2048 by 1536 pixels · 45° FOV
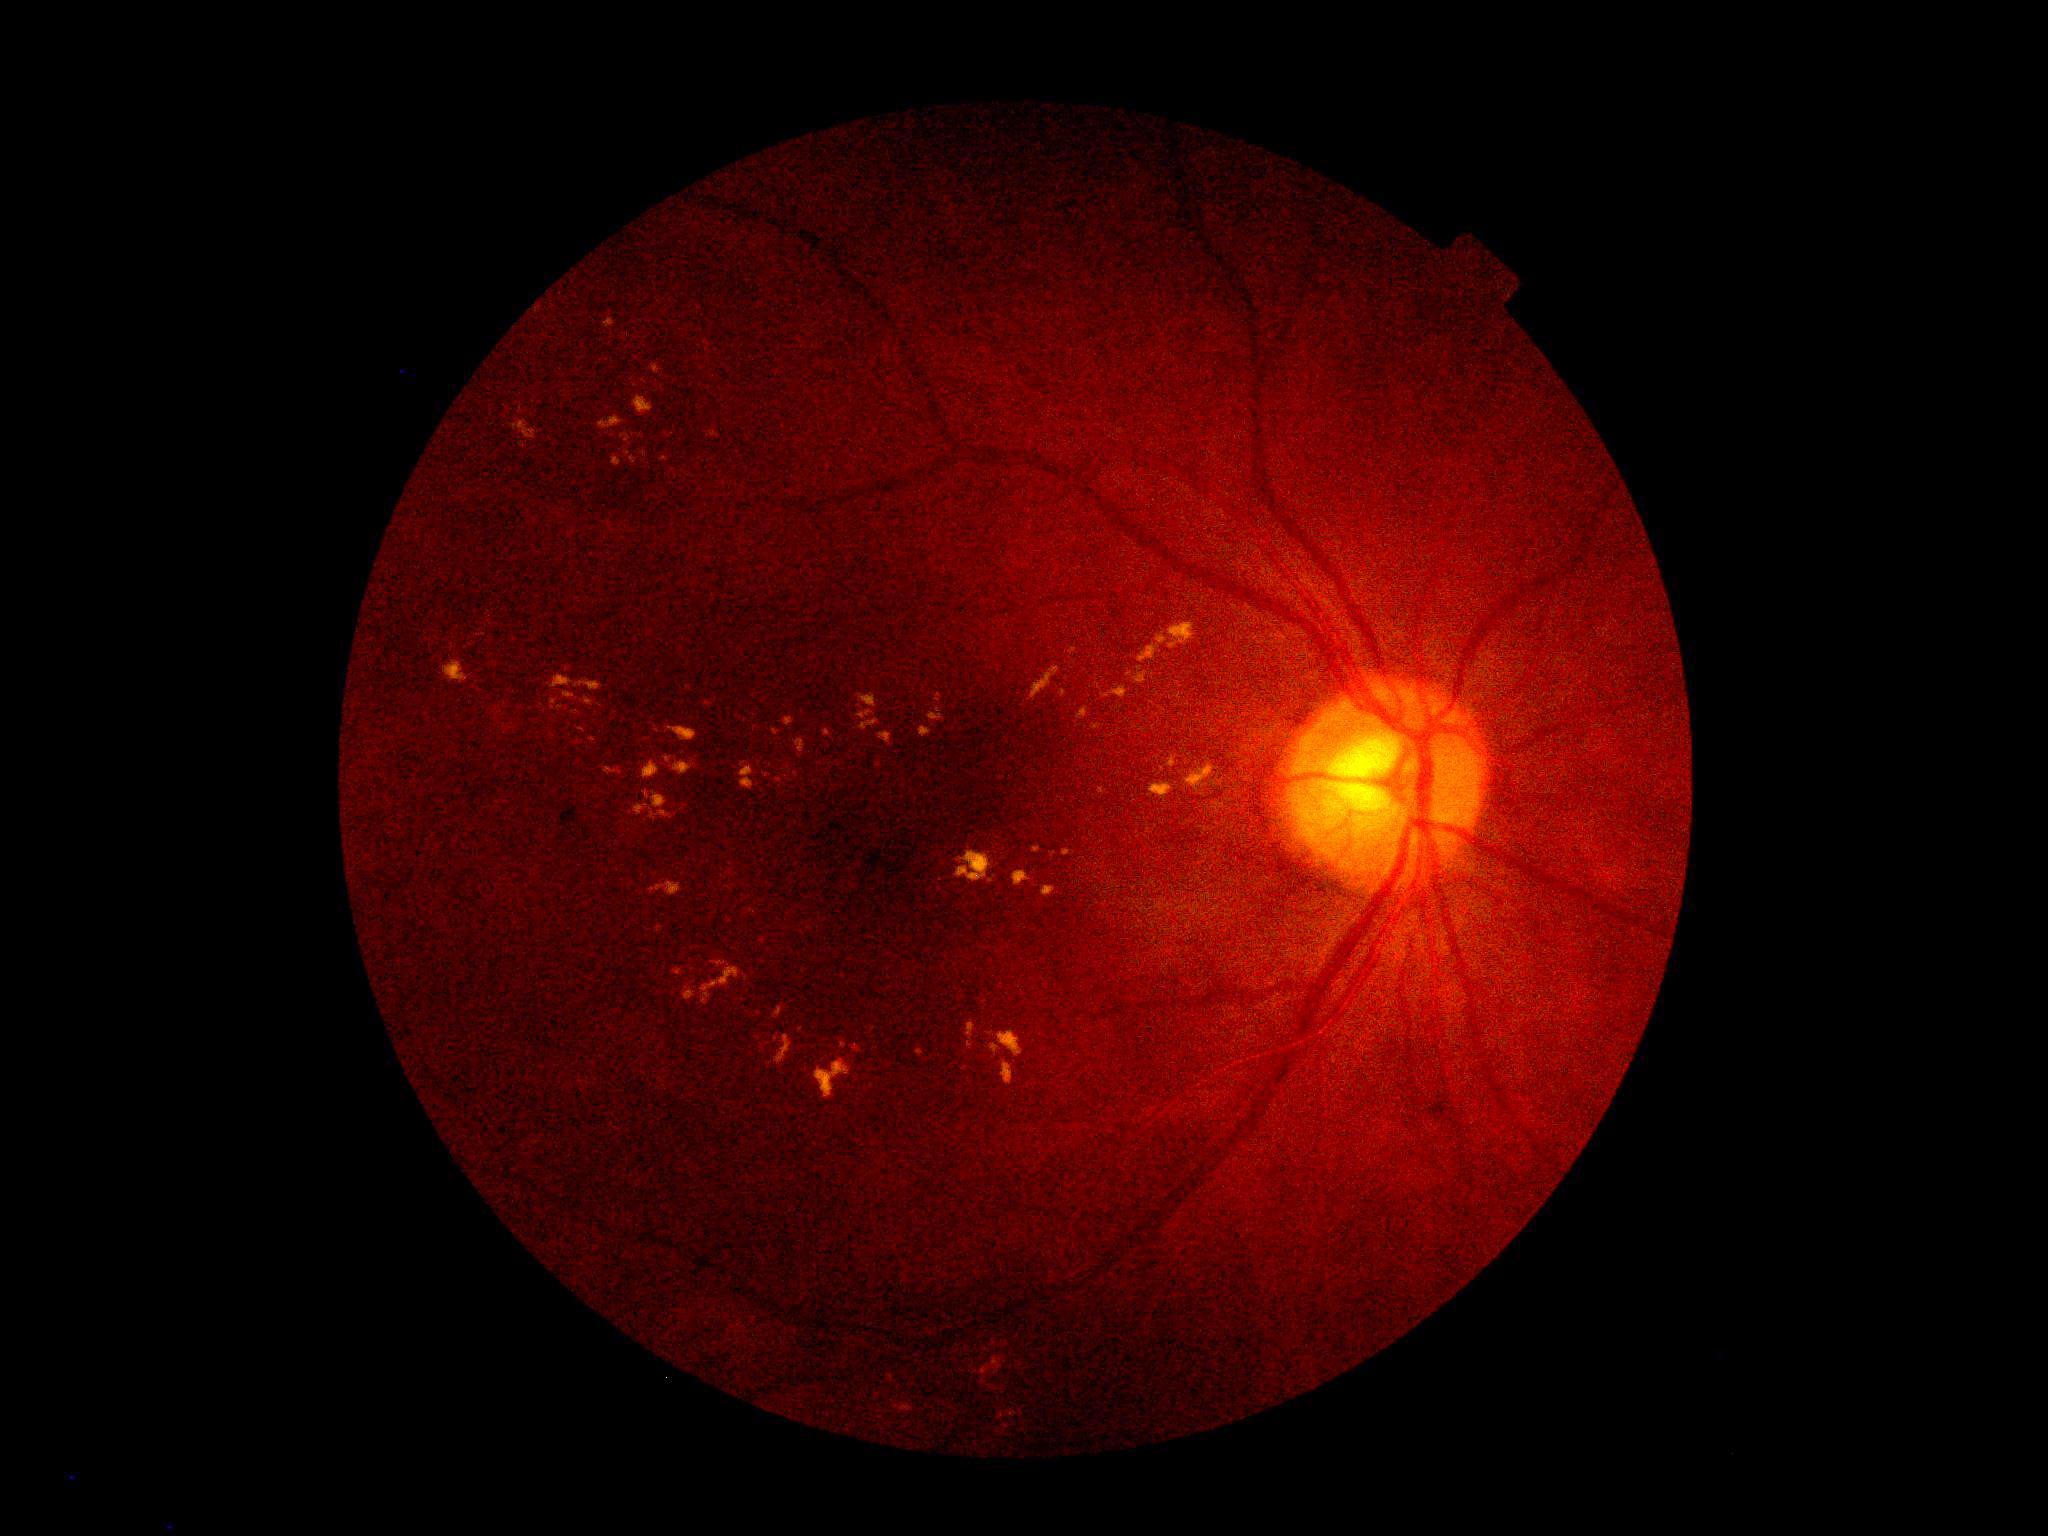

Findings:
– DR class — non-proliferative diabetic retinopathy
– diabetic retinopathy — grade 2 (moderate NPDR)